Modified Davis grading: 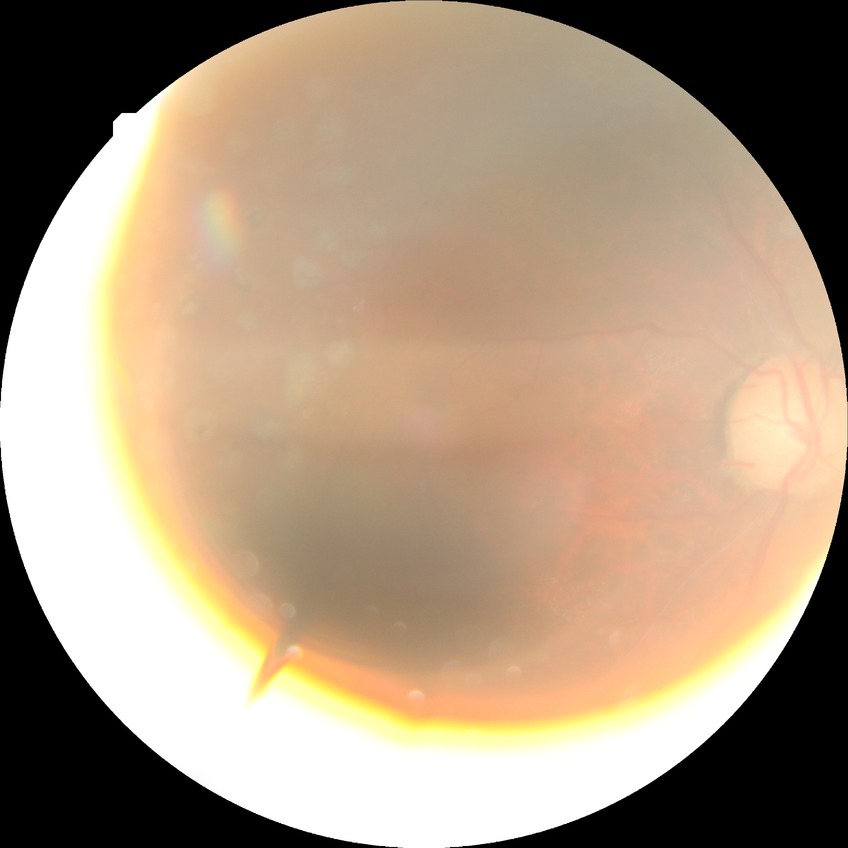 modified Davis grade@PDR.